Disc-centered field: 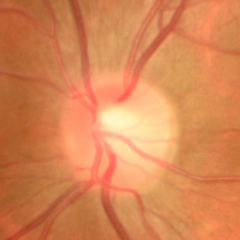 The image shows no glaucomatous optic neuropathy.